848 x 848 pixels. 45° FOV. Retinal fundus photograph.
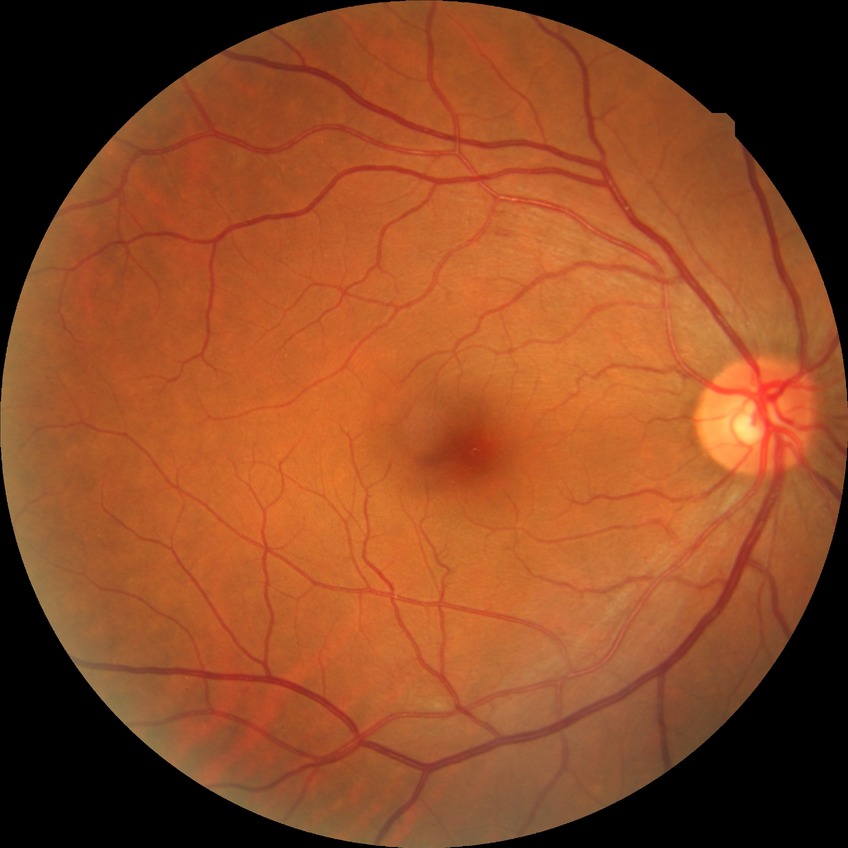

Diabetic retinopathy stage is no diabetic retinopathy.